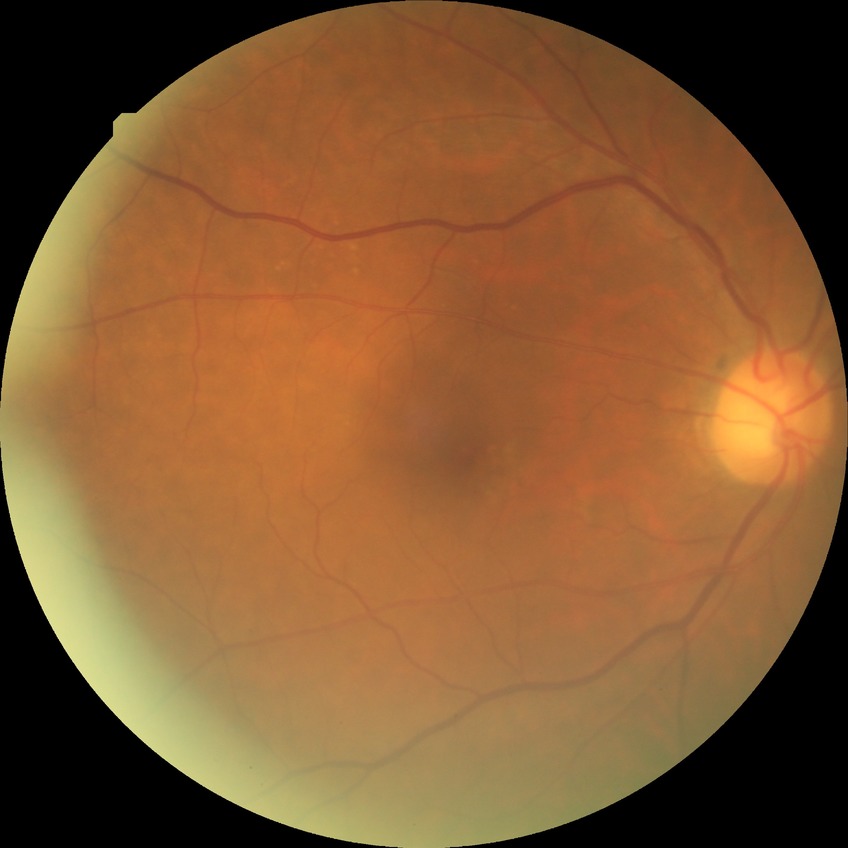

Retinopathy grade is no diabetic retinopathy.